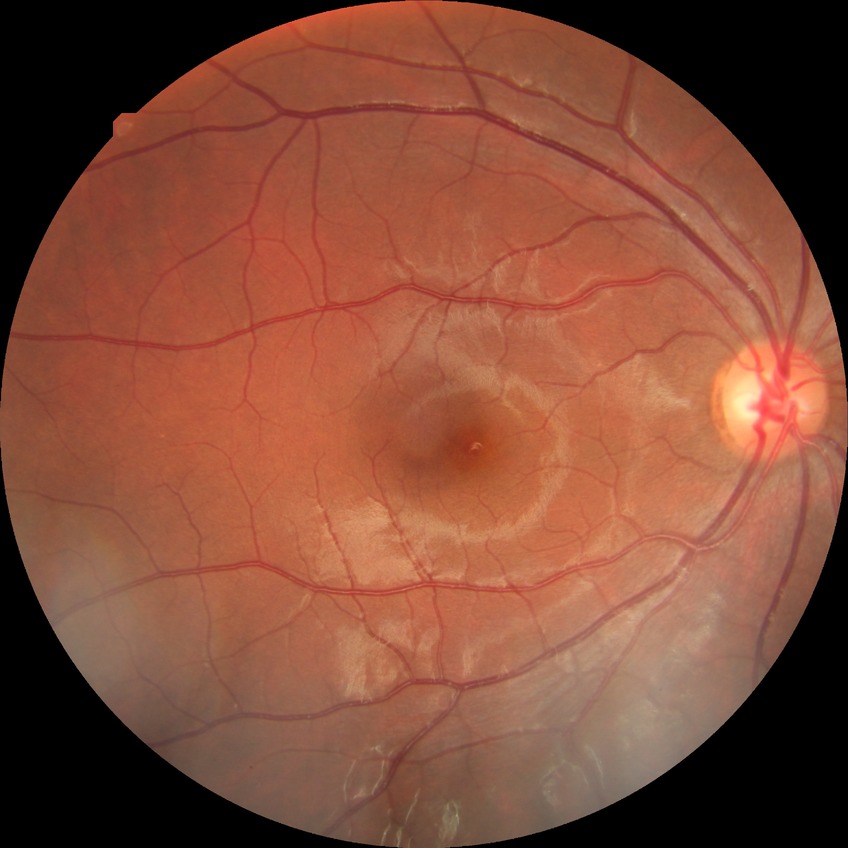
Diabetic retinopathy (DR) is no diabetic retinopathy (NDR).